2212 by 1659 pixels: 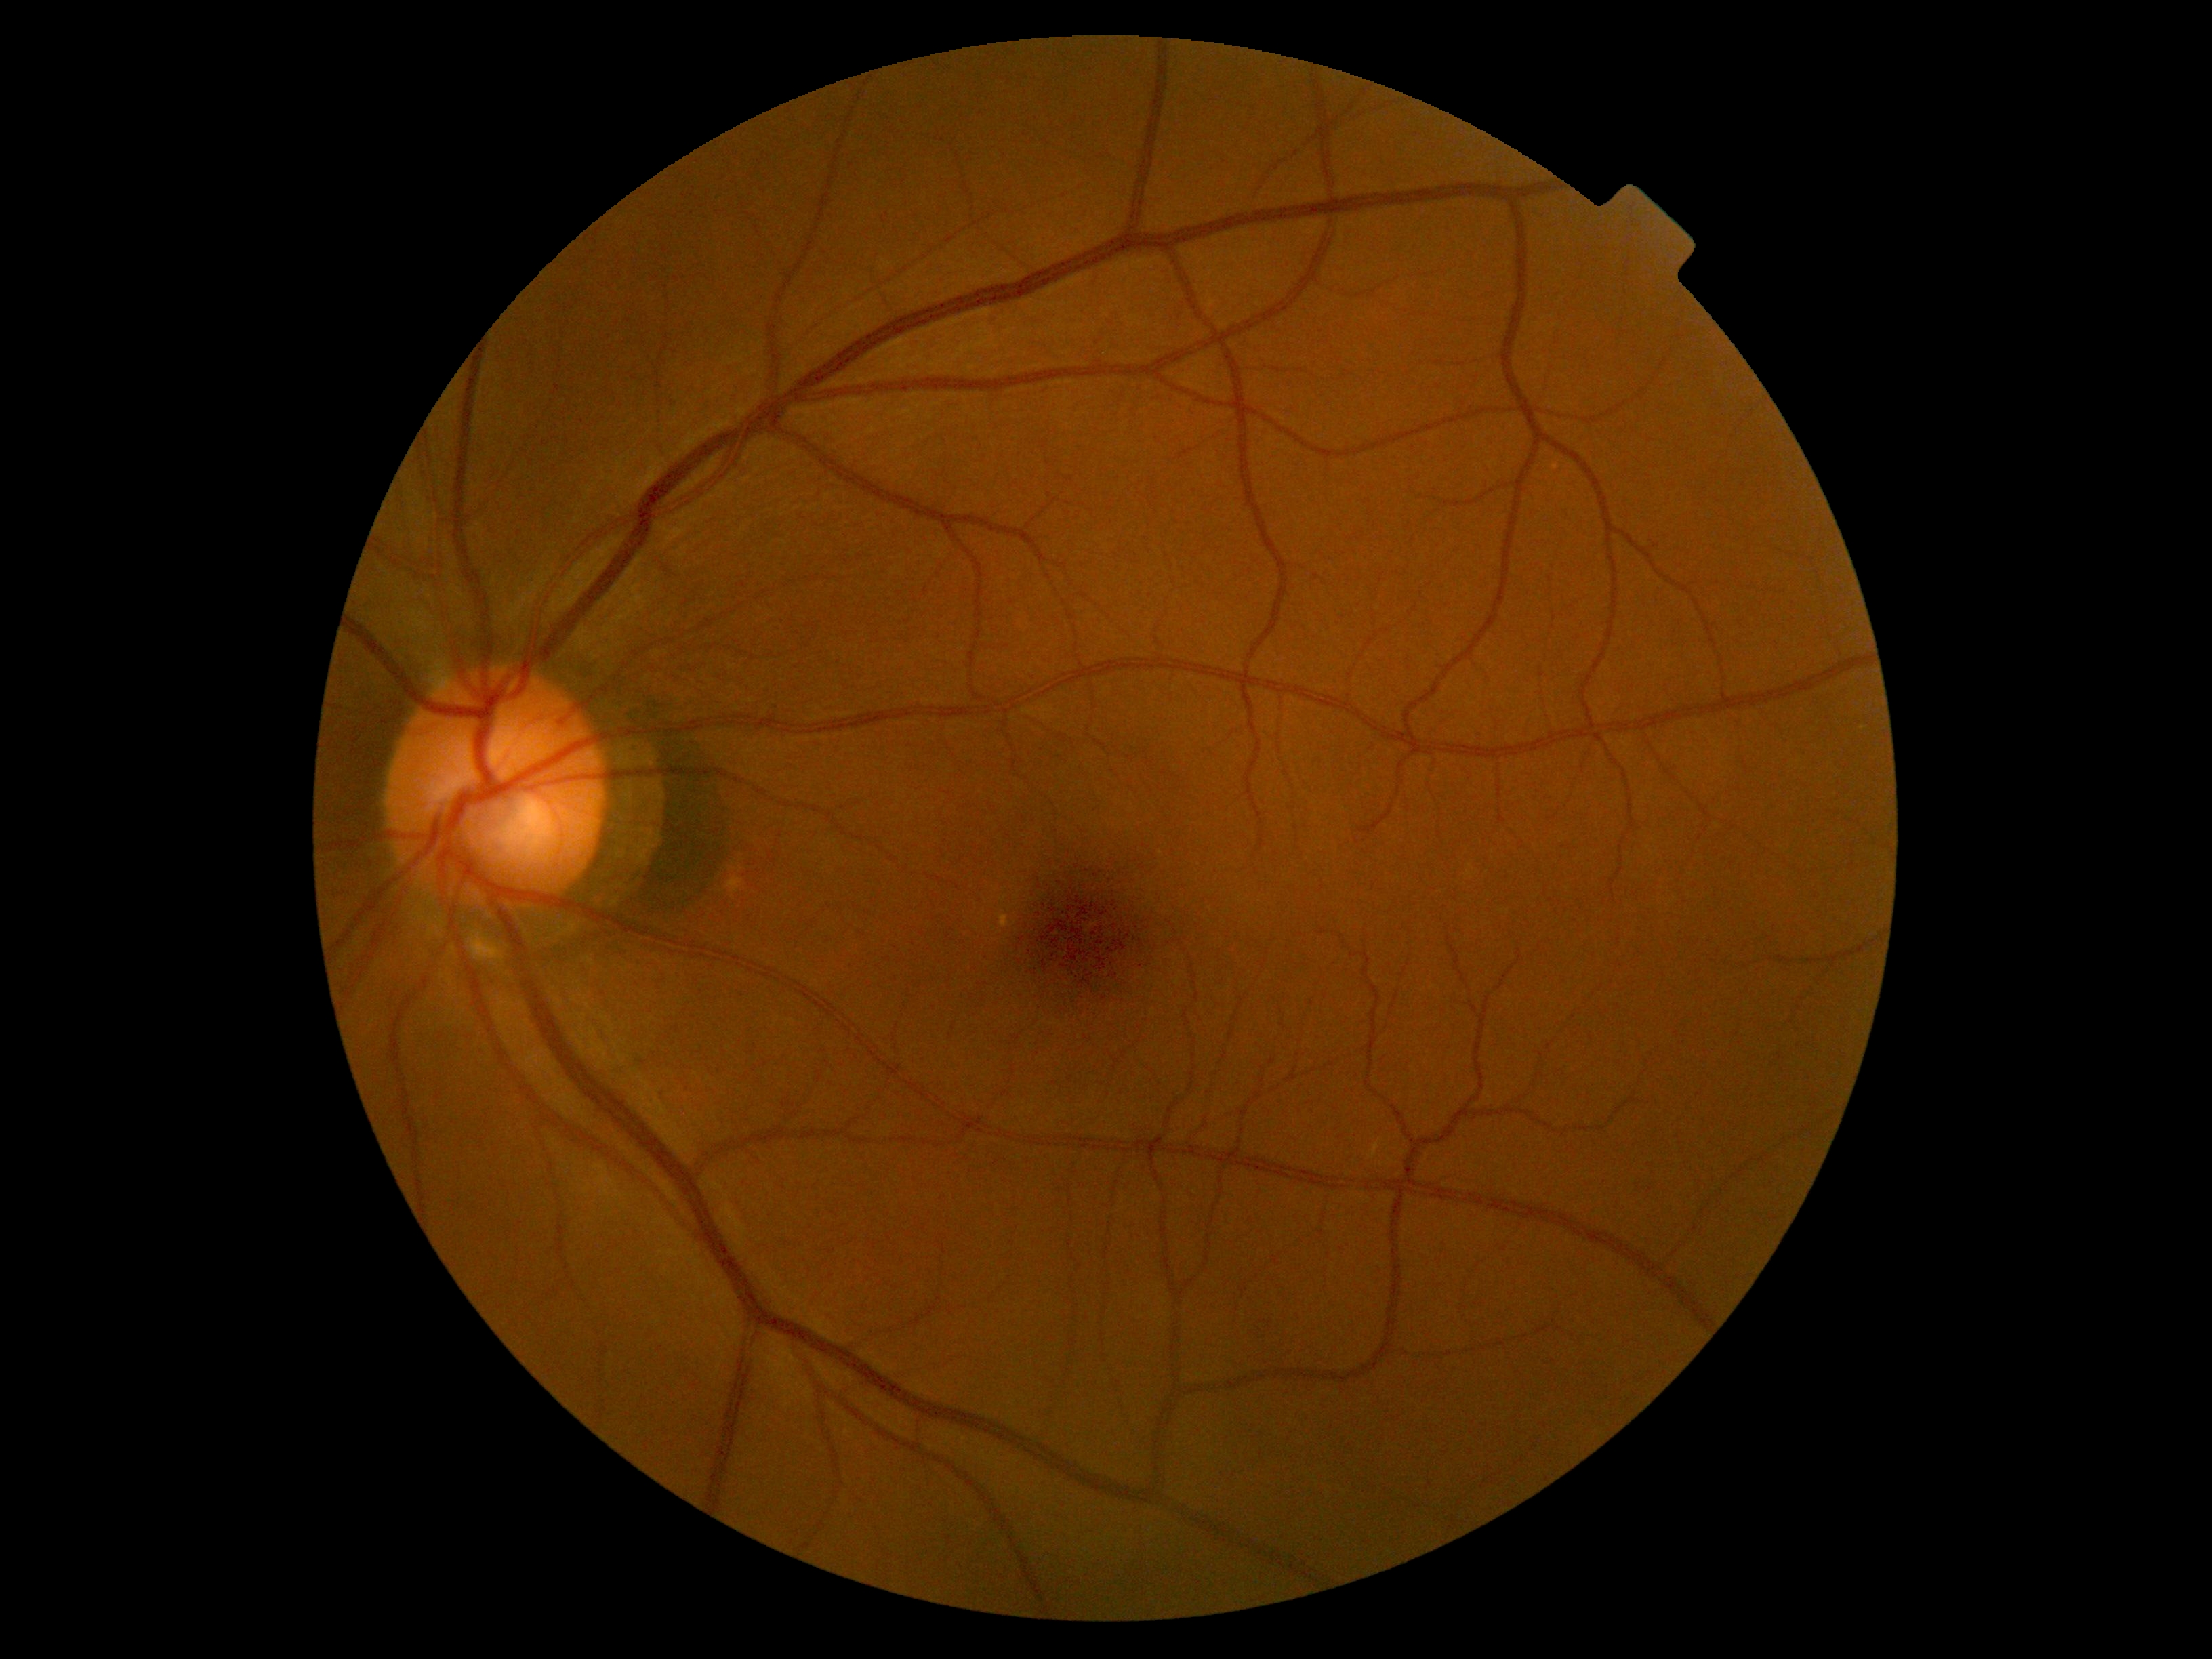

Diabetic retinopathy (DR): no apparent retinopathy (grade 0) — no visible signs of diabetic retinopathy.